45 degree fundus photograph: 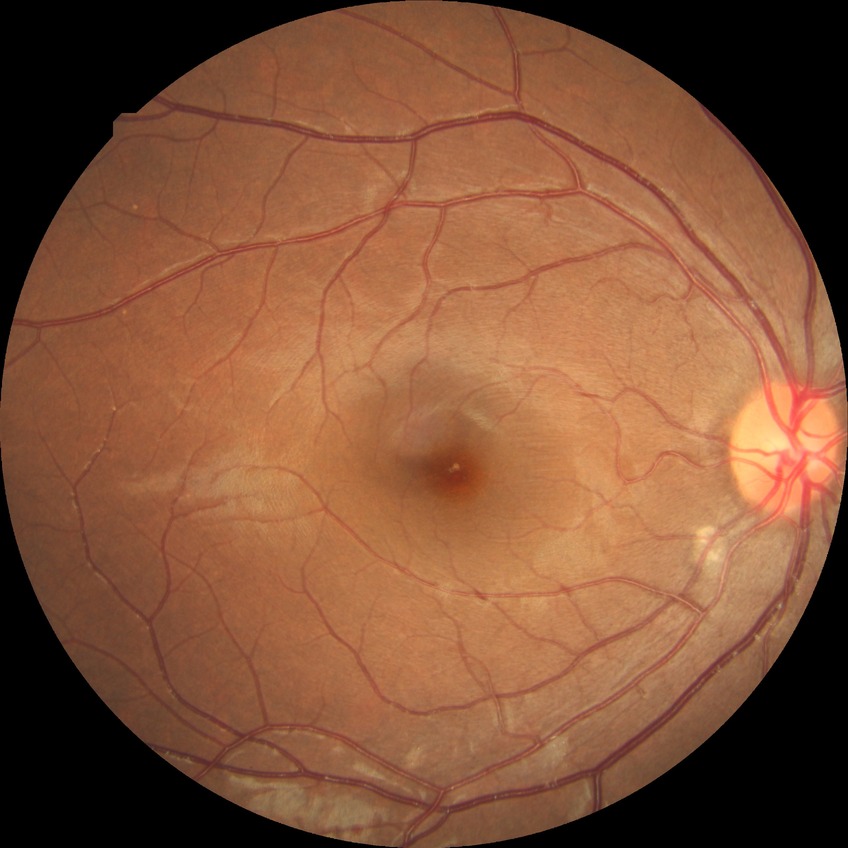 Retinopathy stage: no diabetic retinopathy.